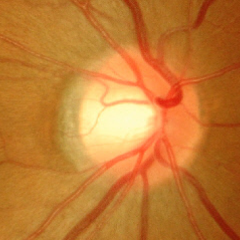 Color fundus photograph showing severe glaucomatous damage. Diagnostic criteria: near-total cupping of the optic nerve head, with or without severe visual field loss within the central 10 degrees of fixation.